FOV: 45 degrees; color fundus photograph; 2212 x 1659 pixels — 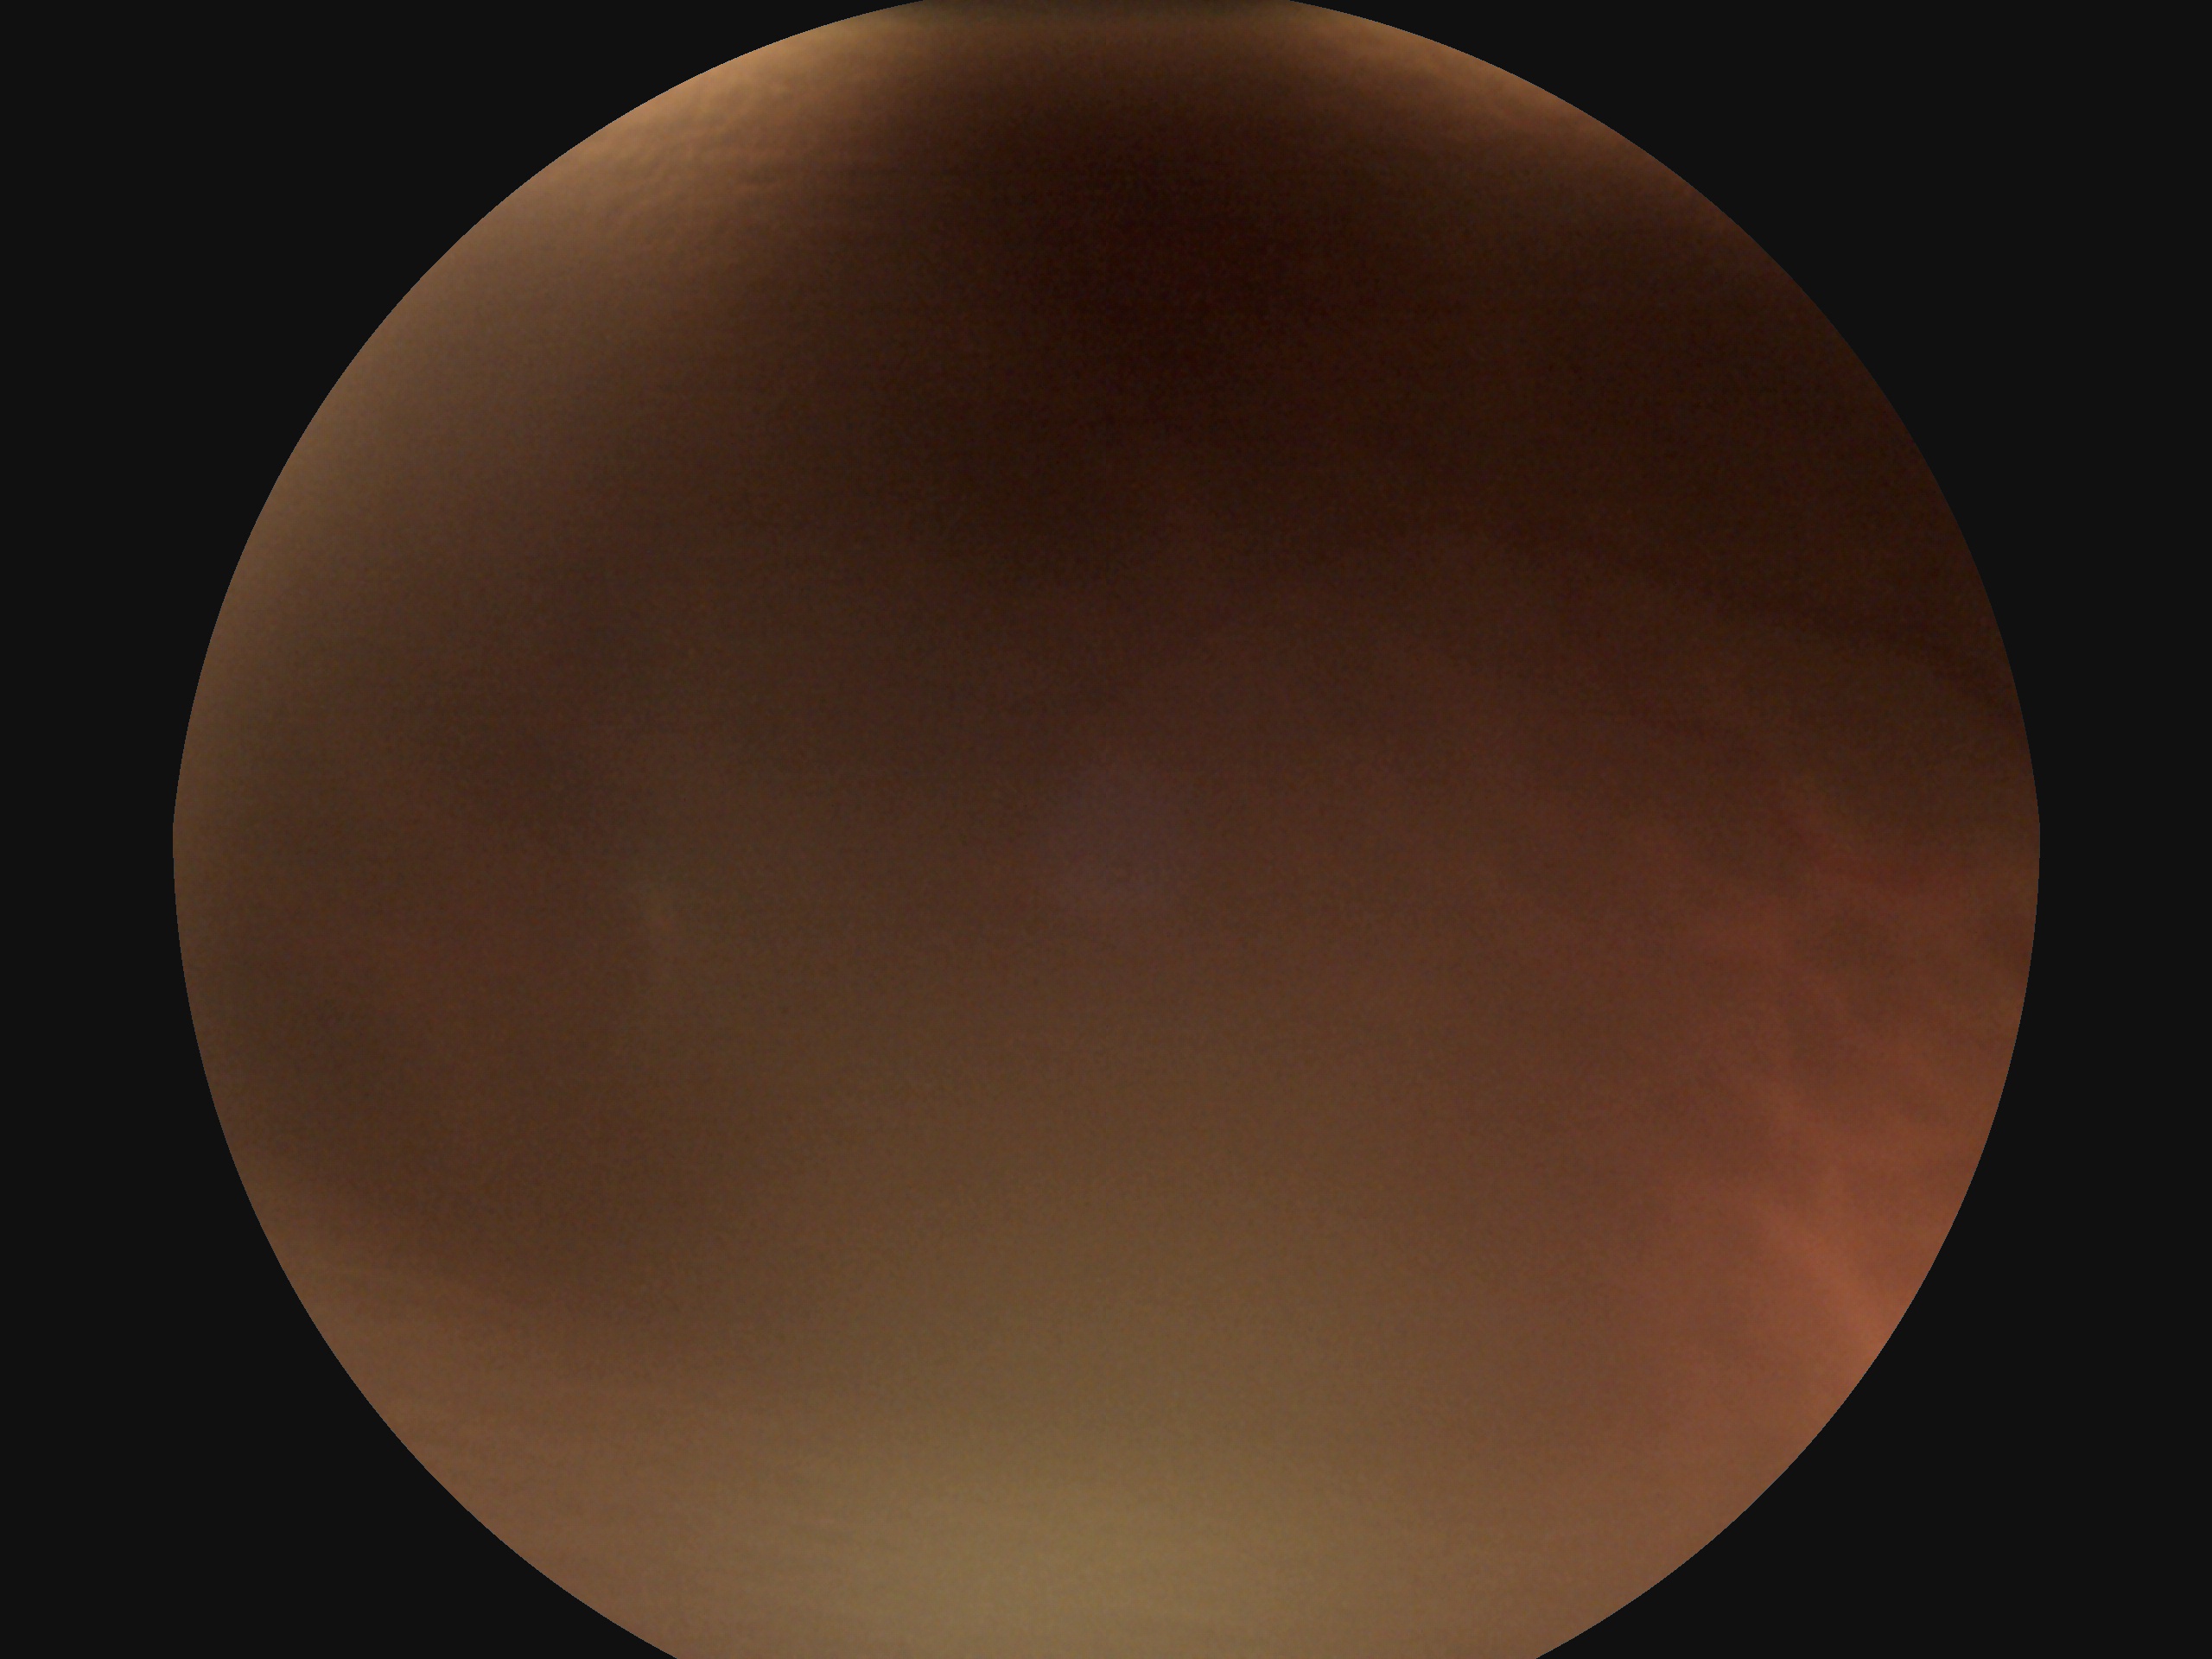 Quality too poor to assess for DR.
DR stage is ungradable.